FOV: 30 degrees. Acquired with a Topcon TRC-NW400
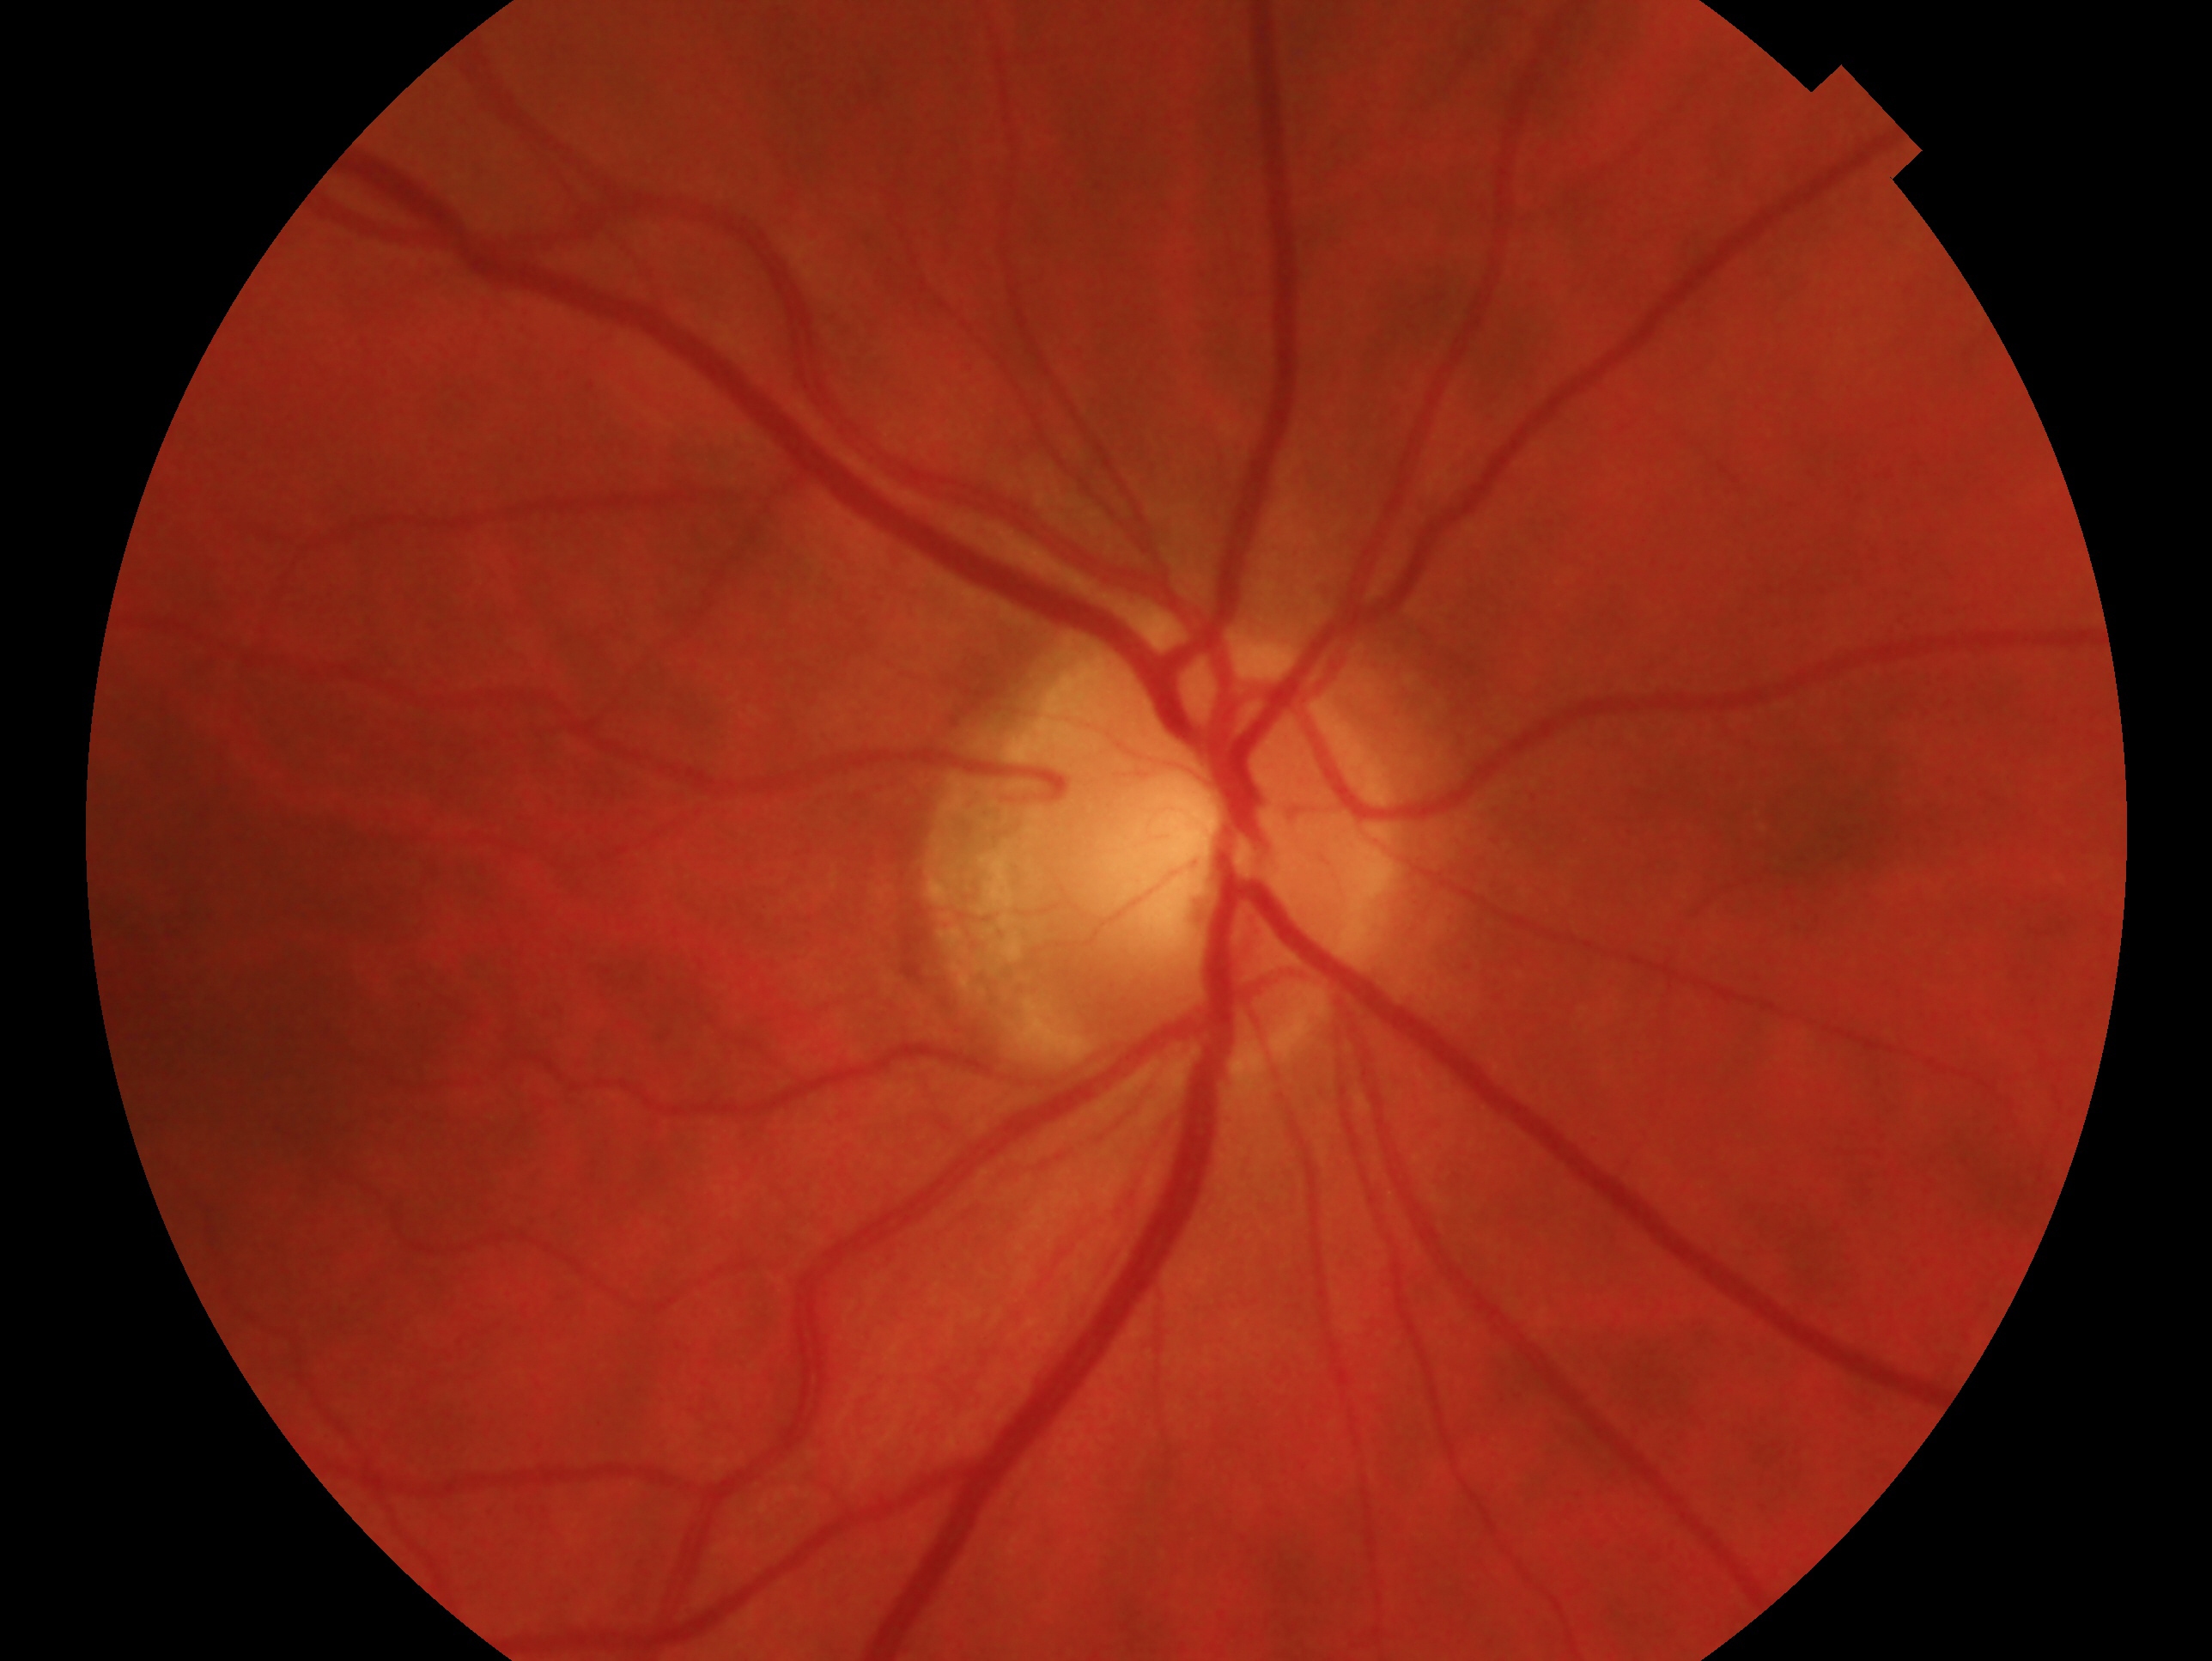

laterality: right eye; glaucoma diagnosis: no glaucoma.